Retinal fundus photograph · camera: Remidio Fundus on Phone · 1659x2212: 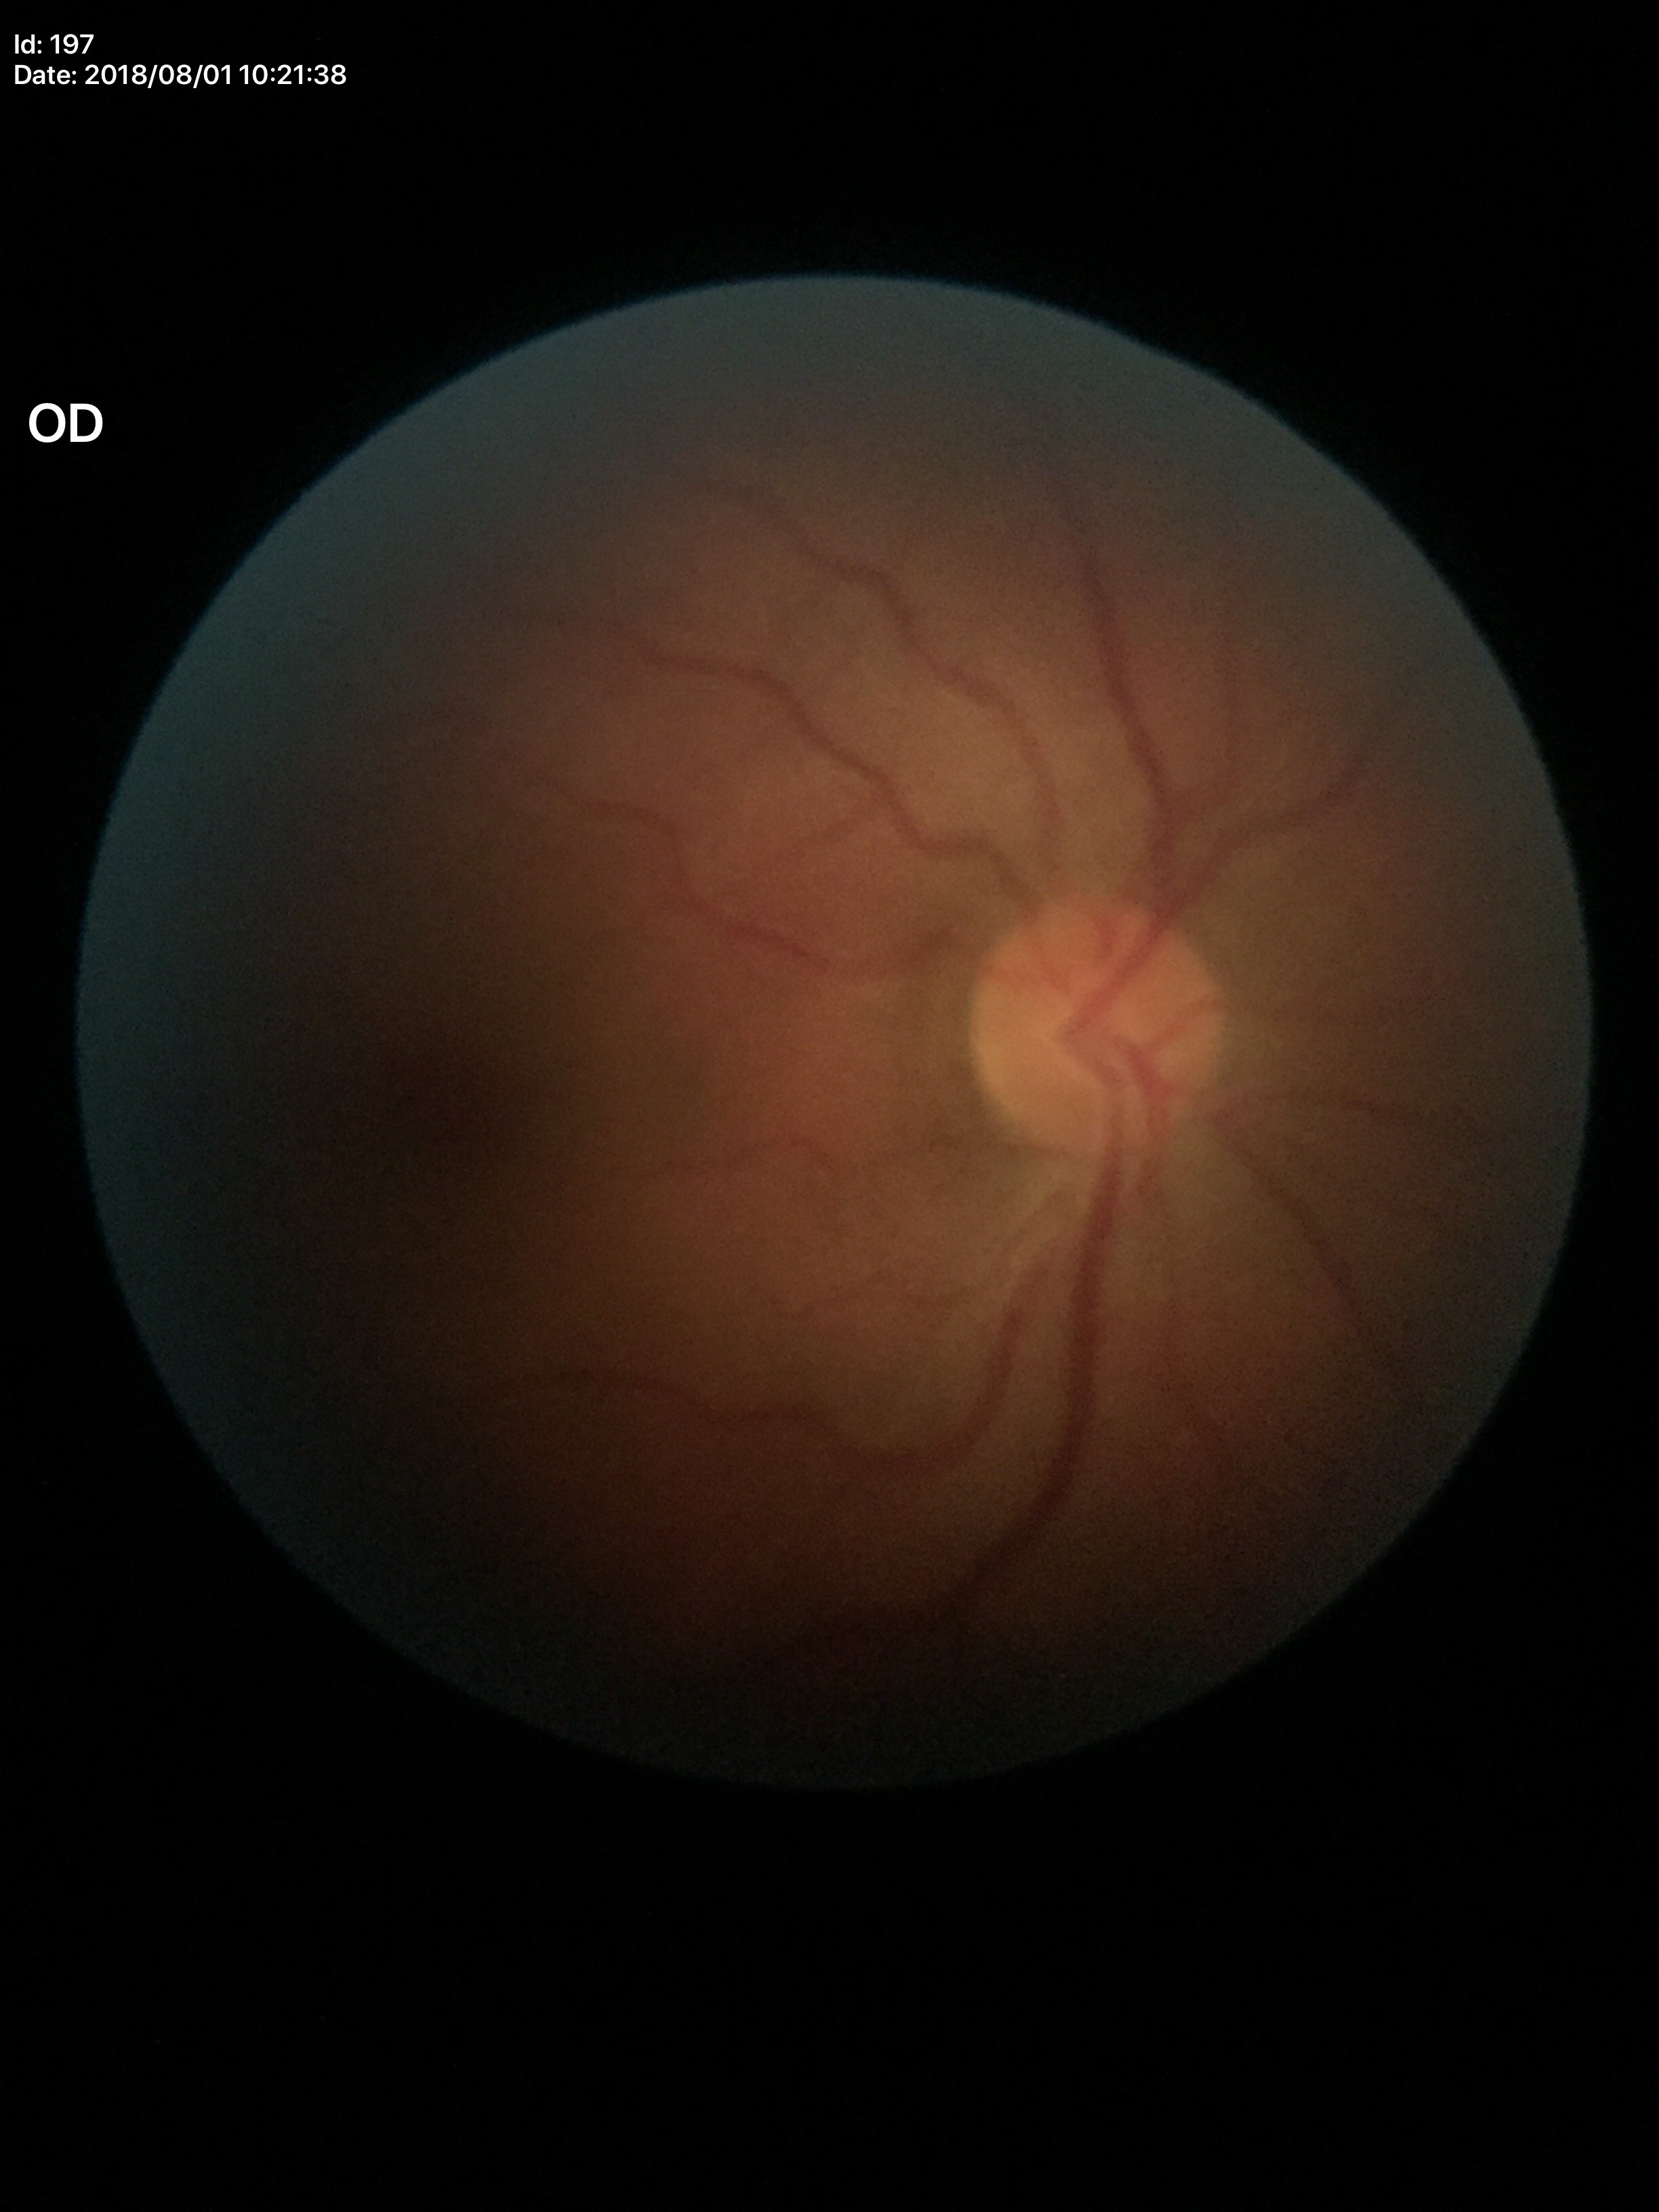
Glaucoma screening impression = not suspect (all 5 graders called normal); vertical CDR (VCDR) = 0.45.